Wide-field contact fundus photograph of an infant. Captured with the Phoenix ICON (100° field of view): 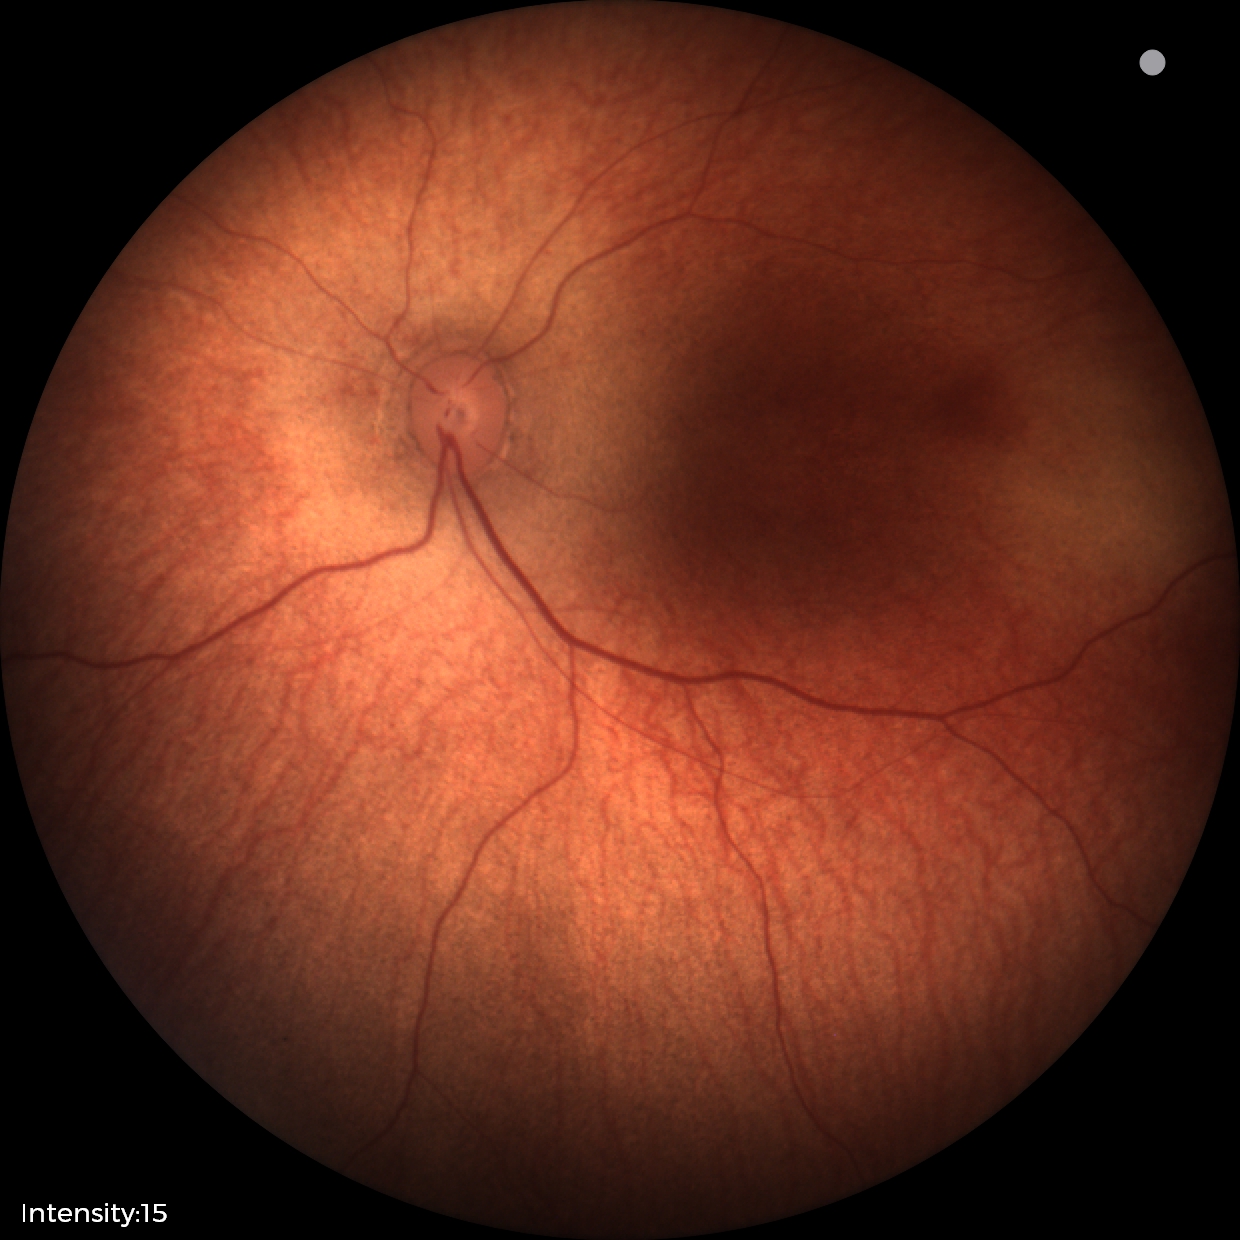
Normal screening examination.